NIDEK AFC-230.
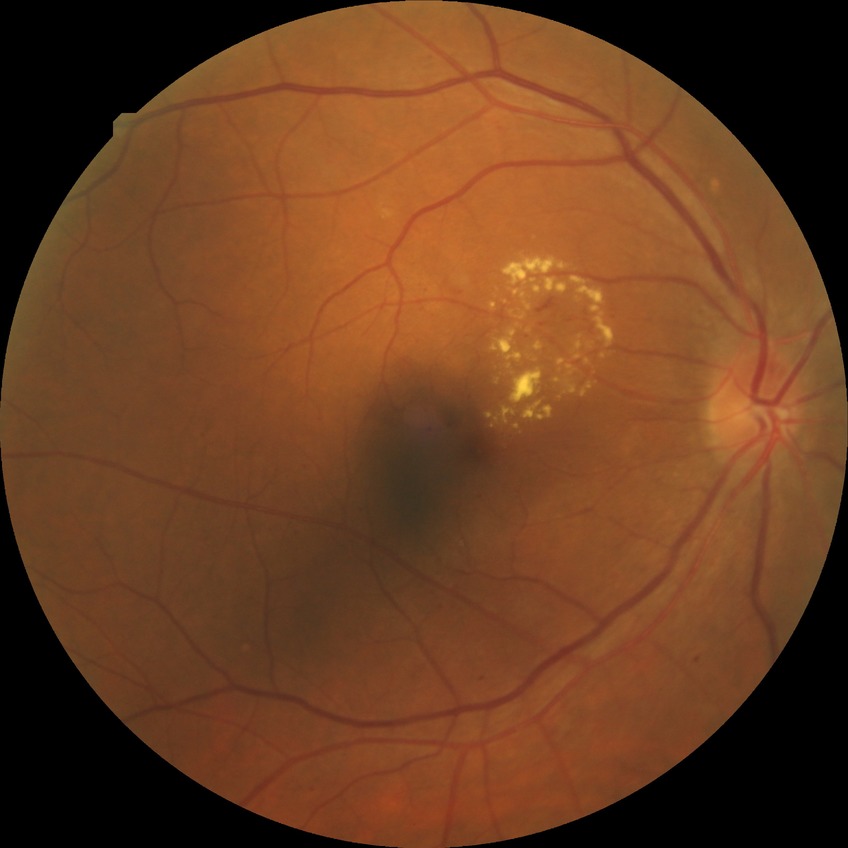
Diabetic retinopathy (DR) is simple diabetic retinopathy (SDR).